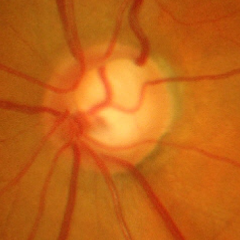 Optic nerve head appearance consistent with severe glaucomatous damage.